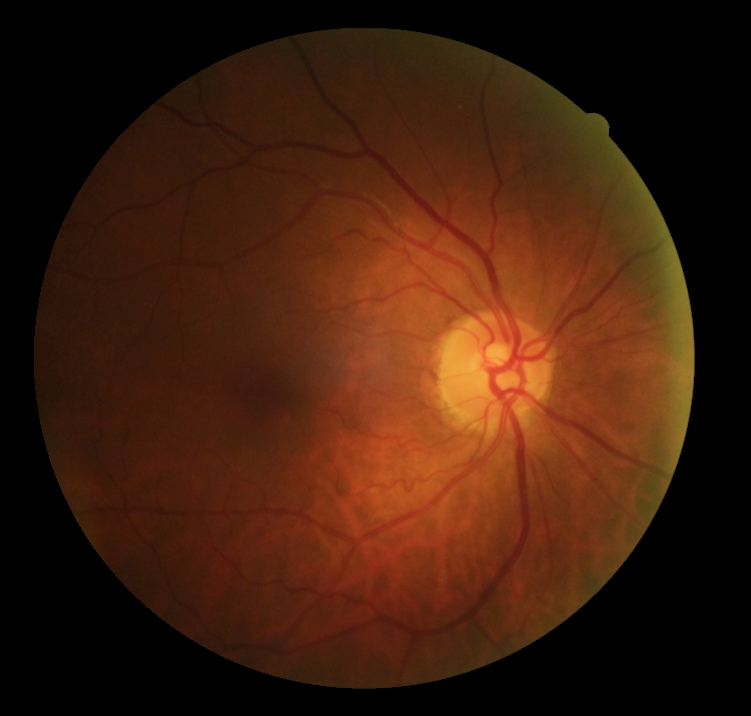 DR impression: no DR findings; retinopathy grade: 0/4.